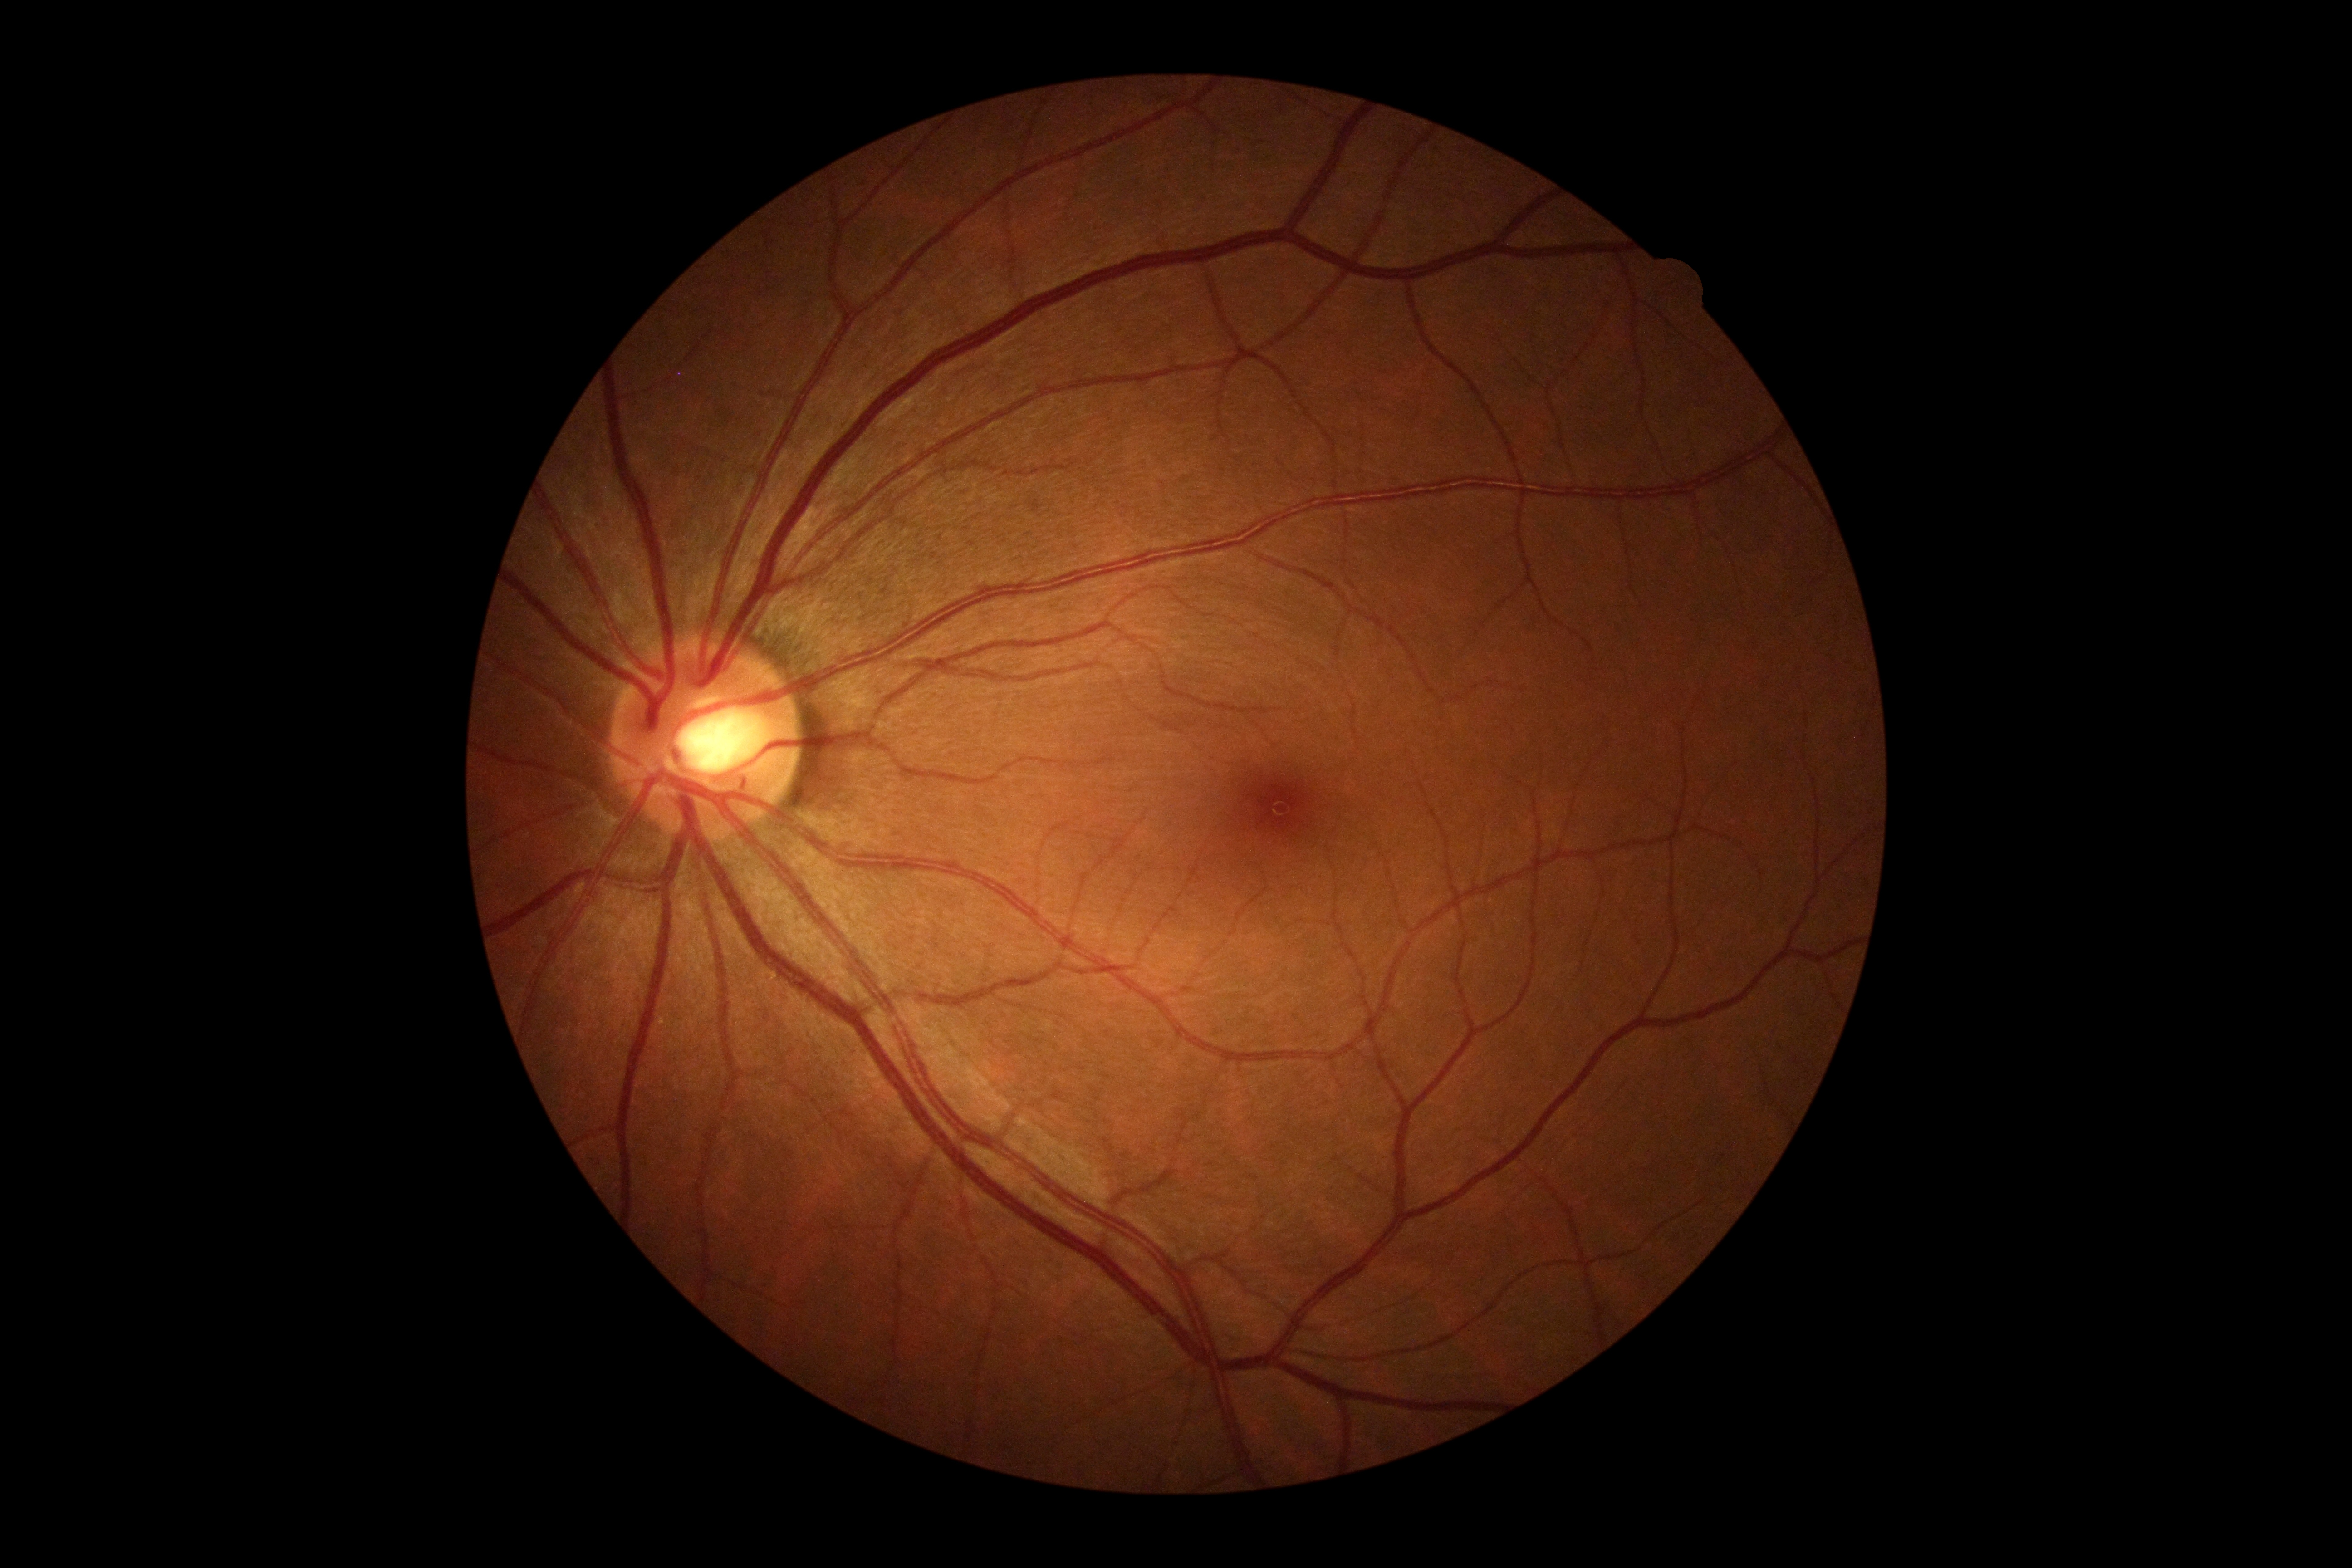

retinopathy = no apparent diabetic retinopathy (grade 0)